CFP — 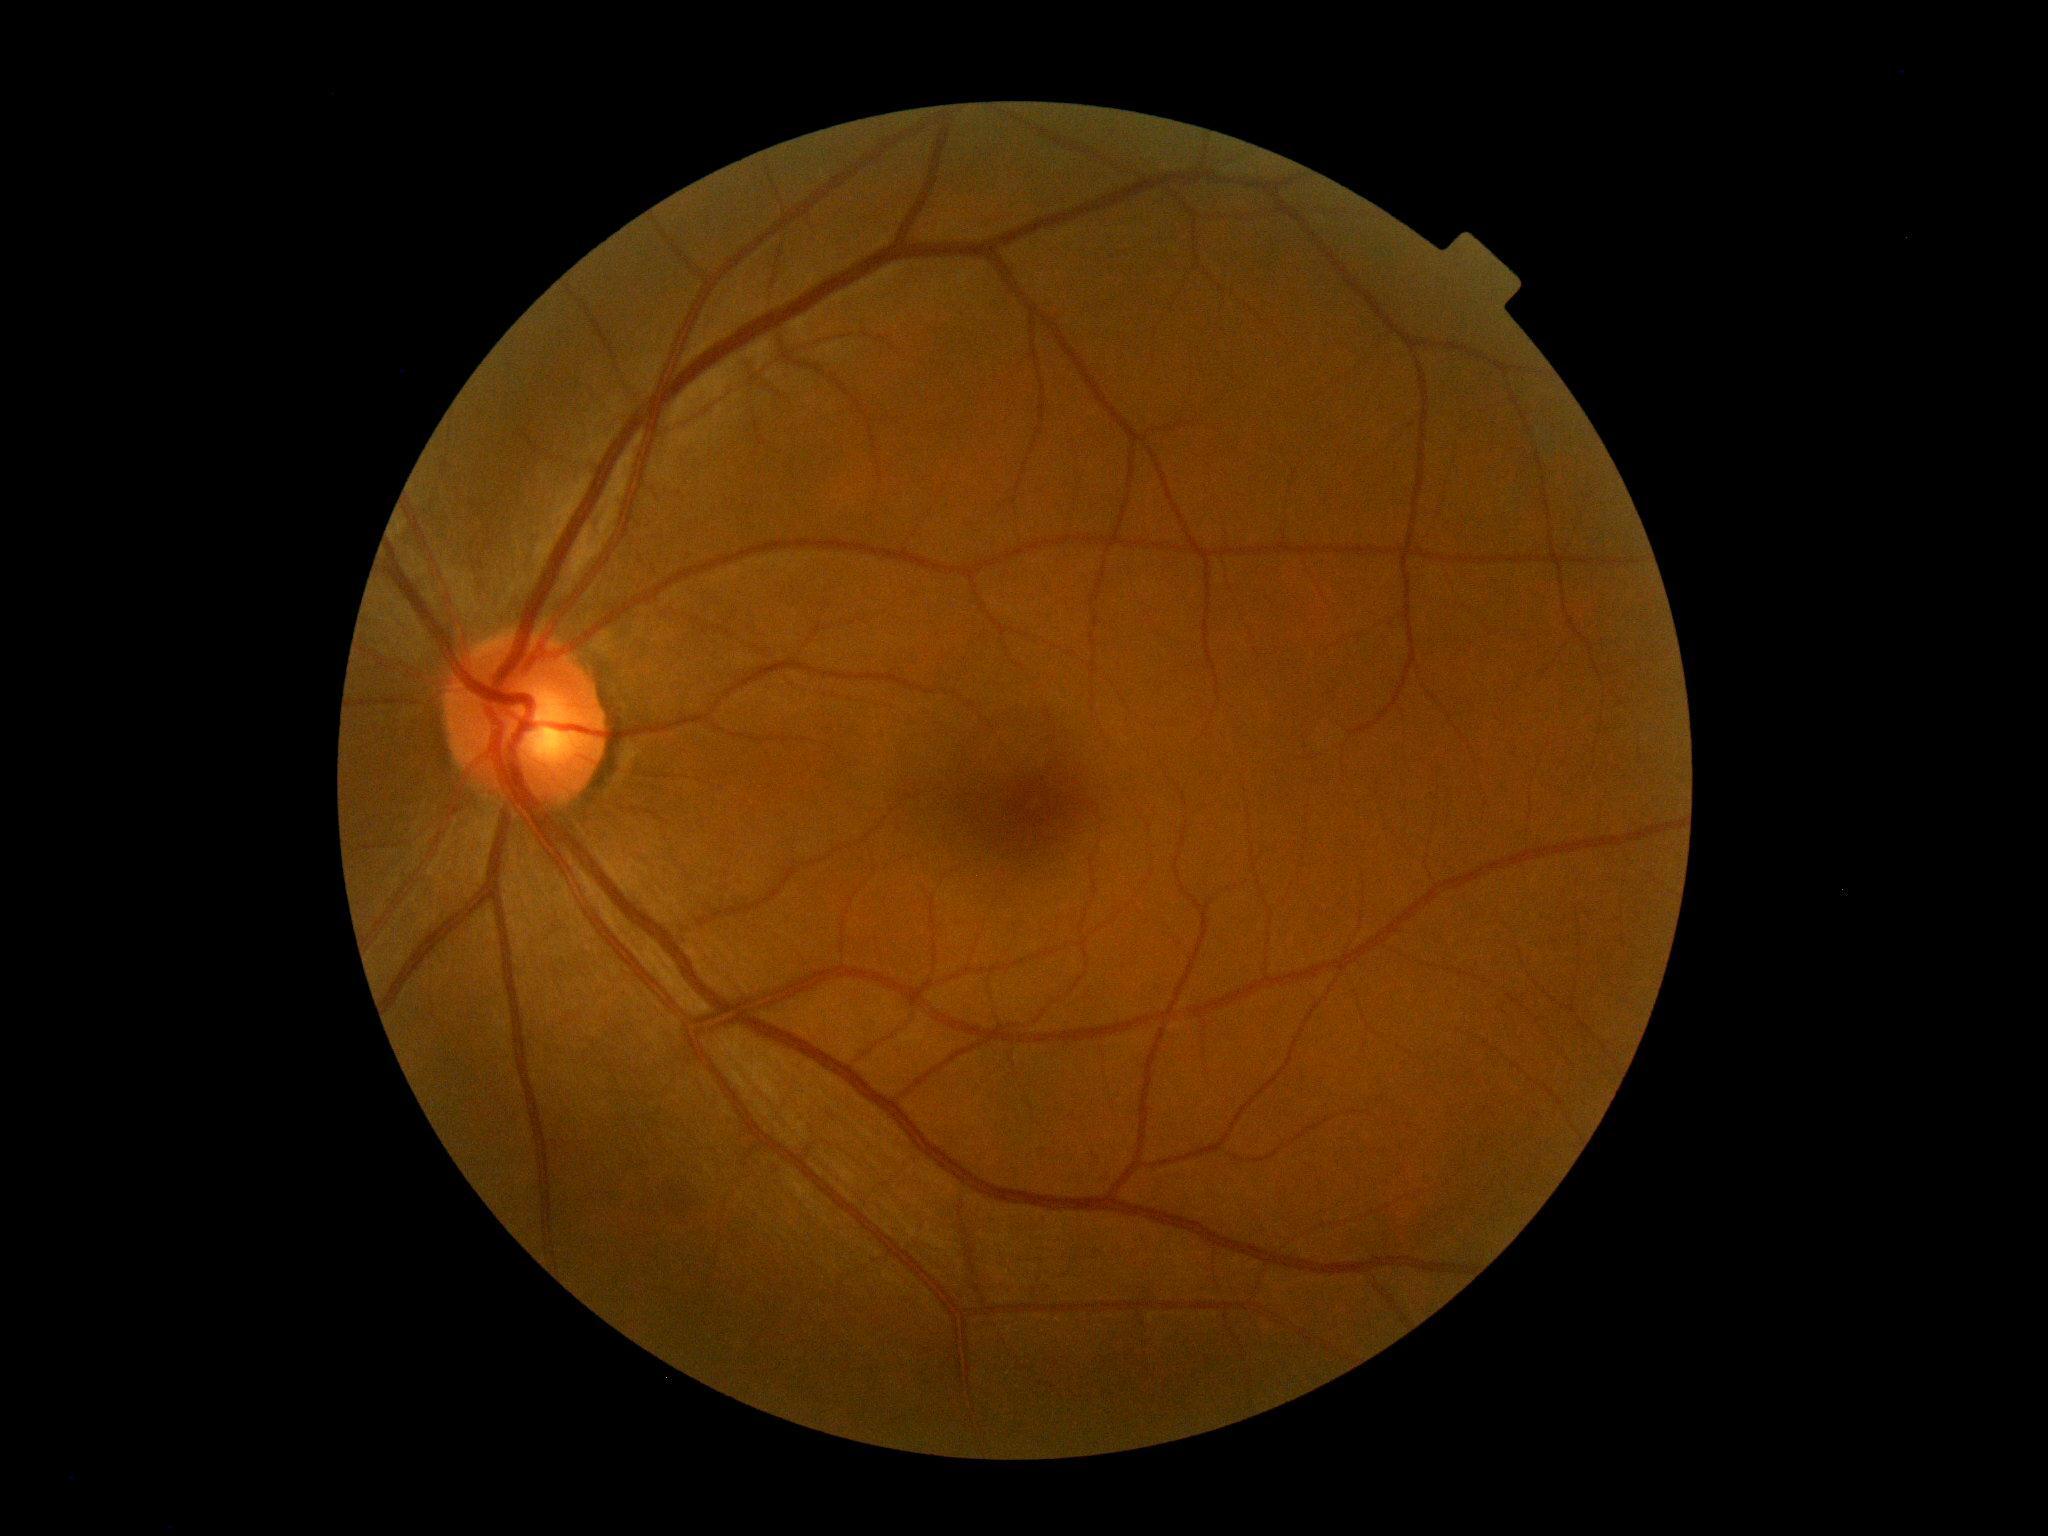
DR: 0/4.